Fundus photo
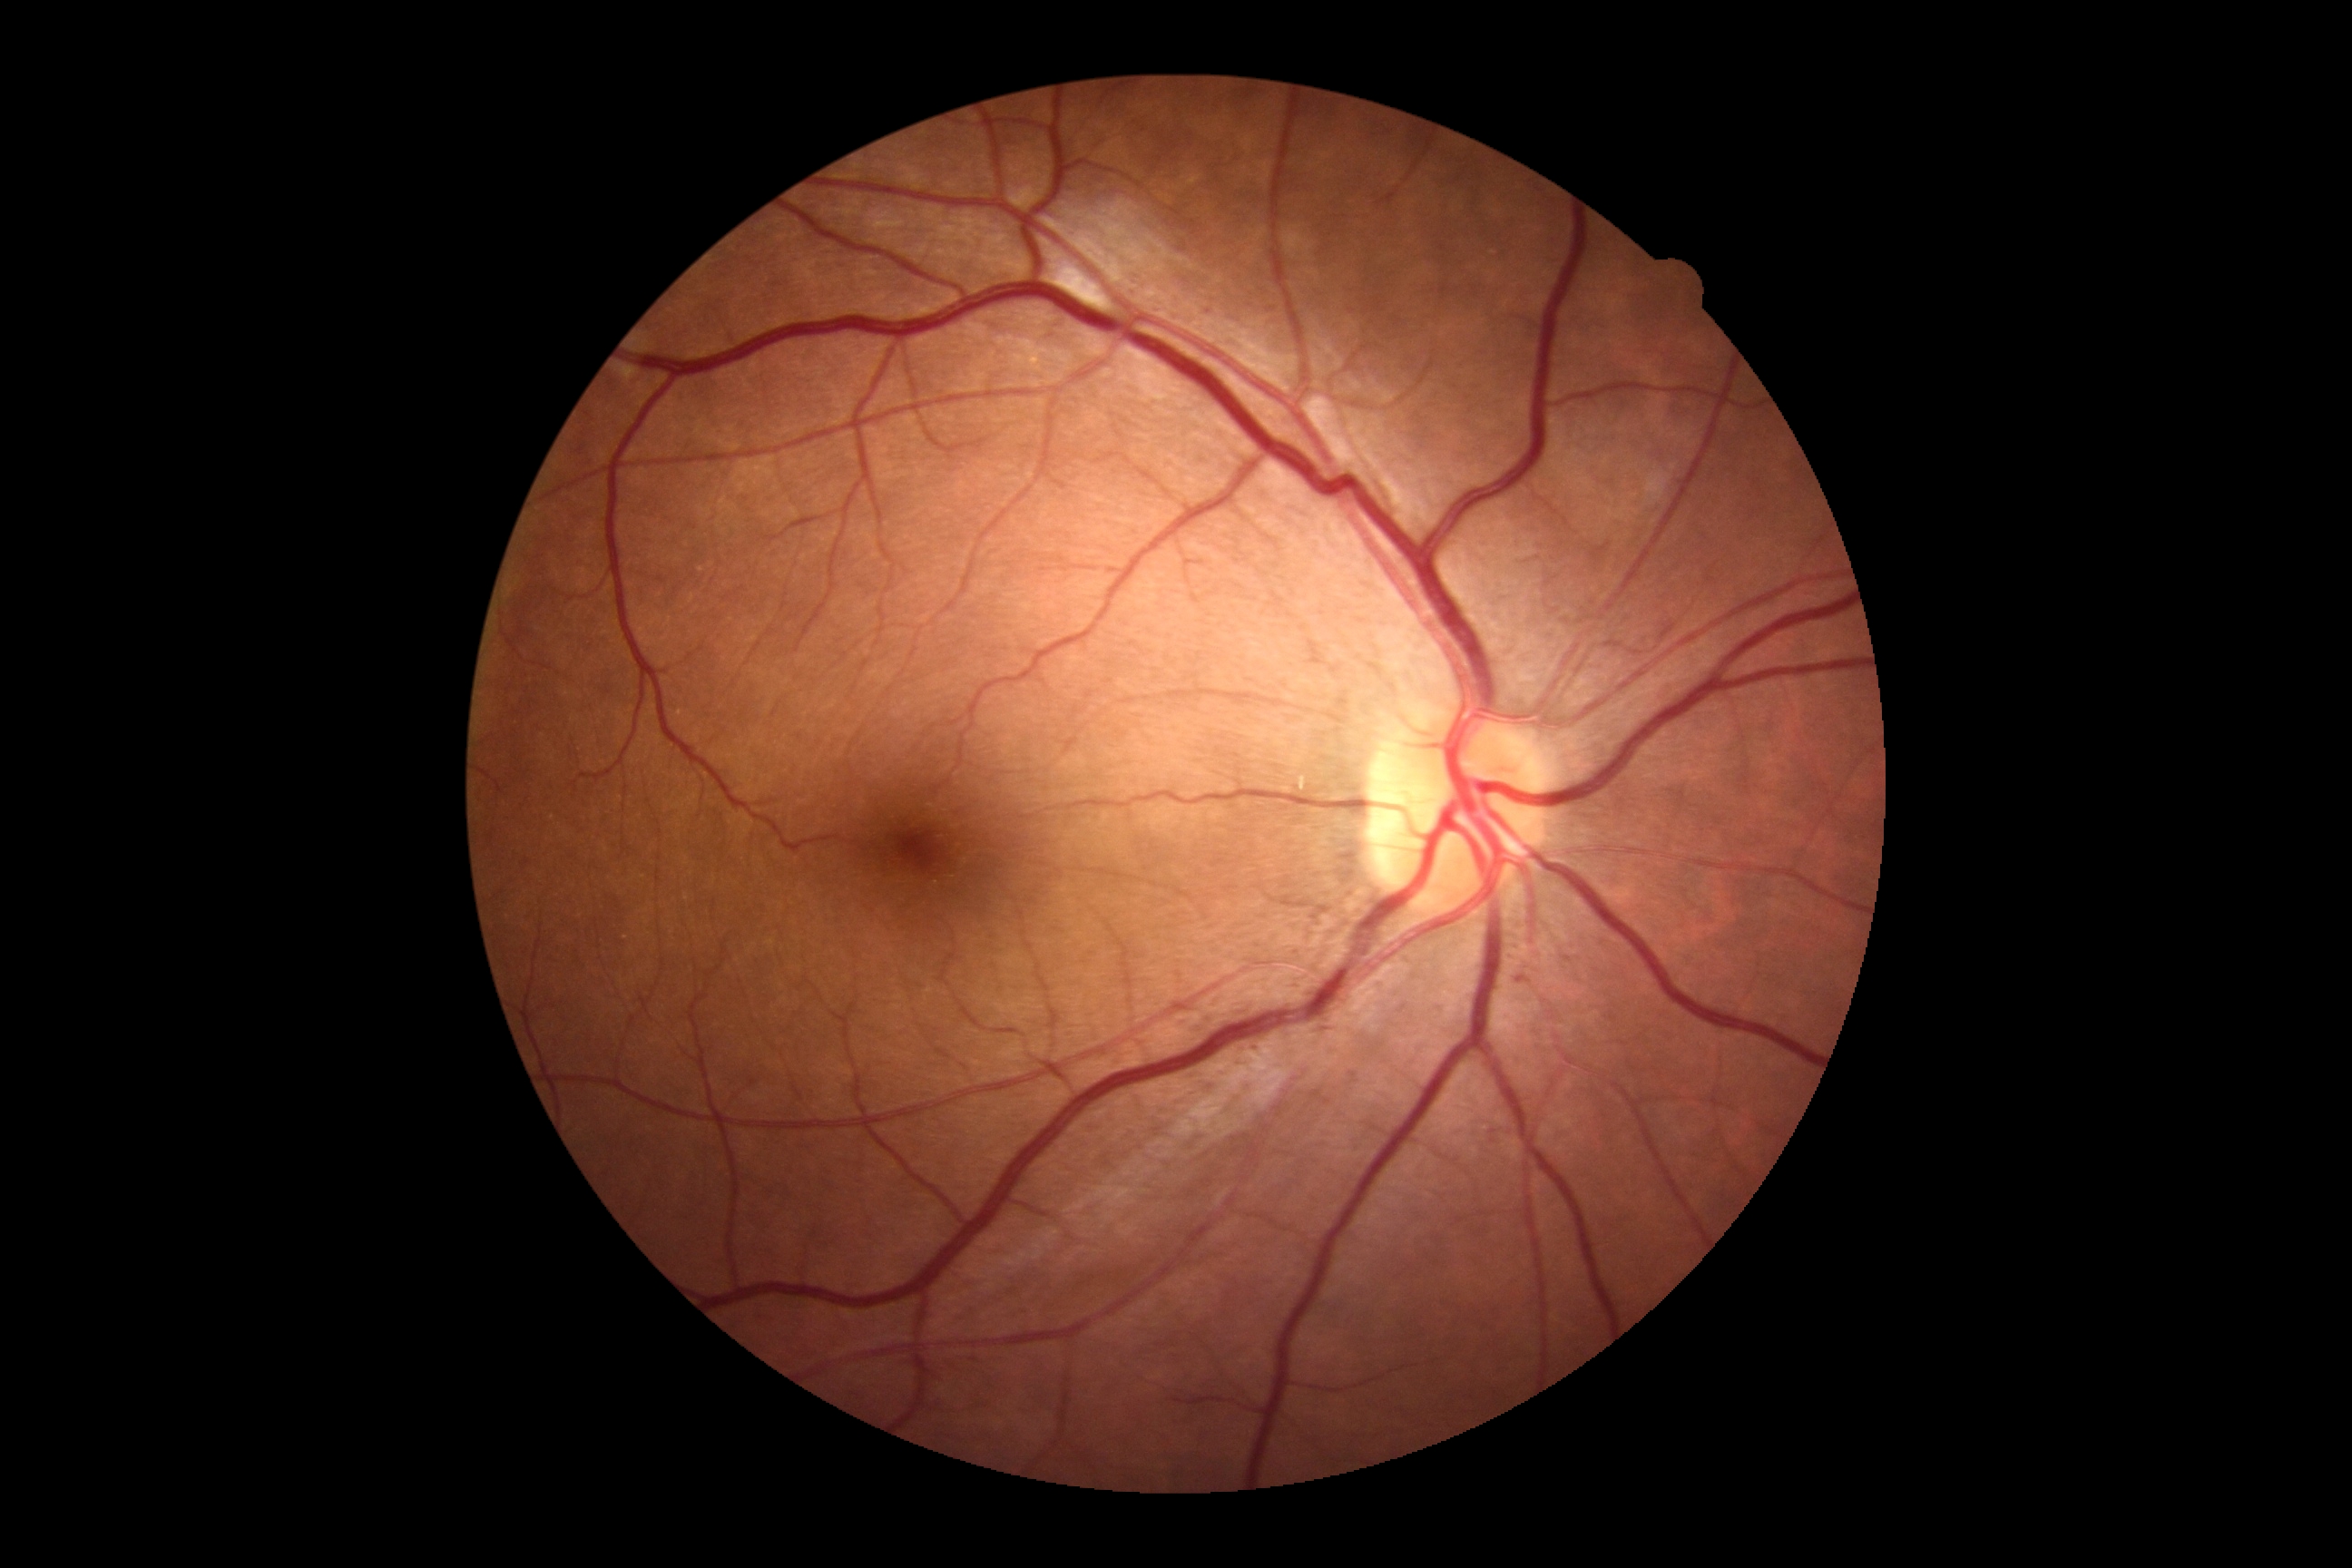 Annotations:
• diabetic retinopathy (DR): grade 2 (moderate NPDR)